Wide-field fundus photograph of an infant: 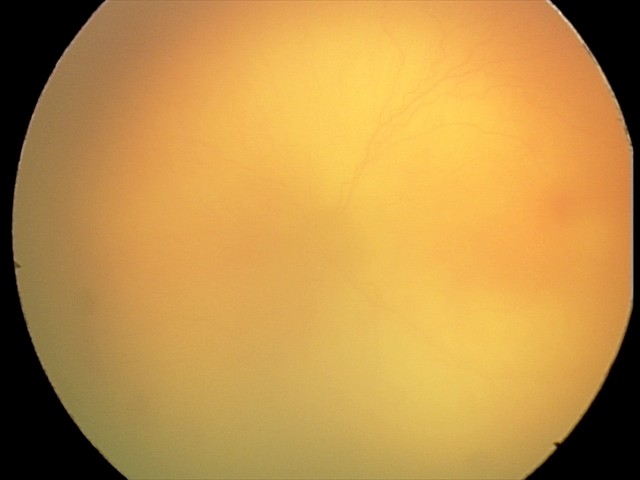

Screening examination consistent with aggressive retinopathy of prematurity. Plus disease was diagnosed.